45-degree field of view. Image size 2184x1690. Fundus photo — 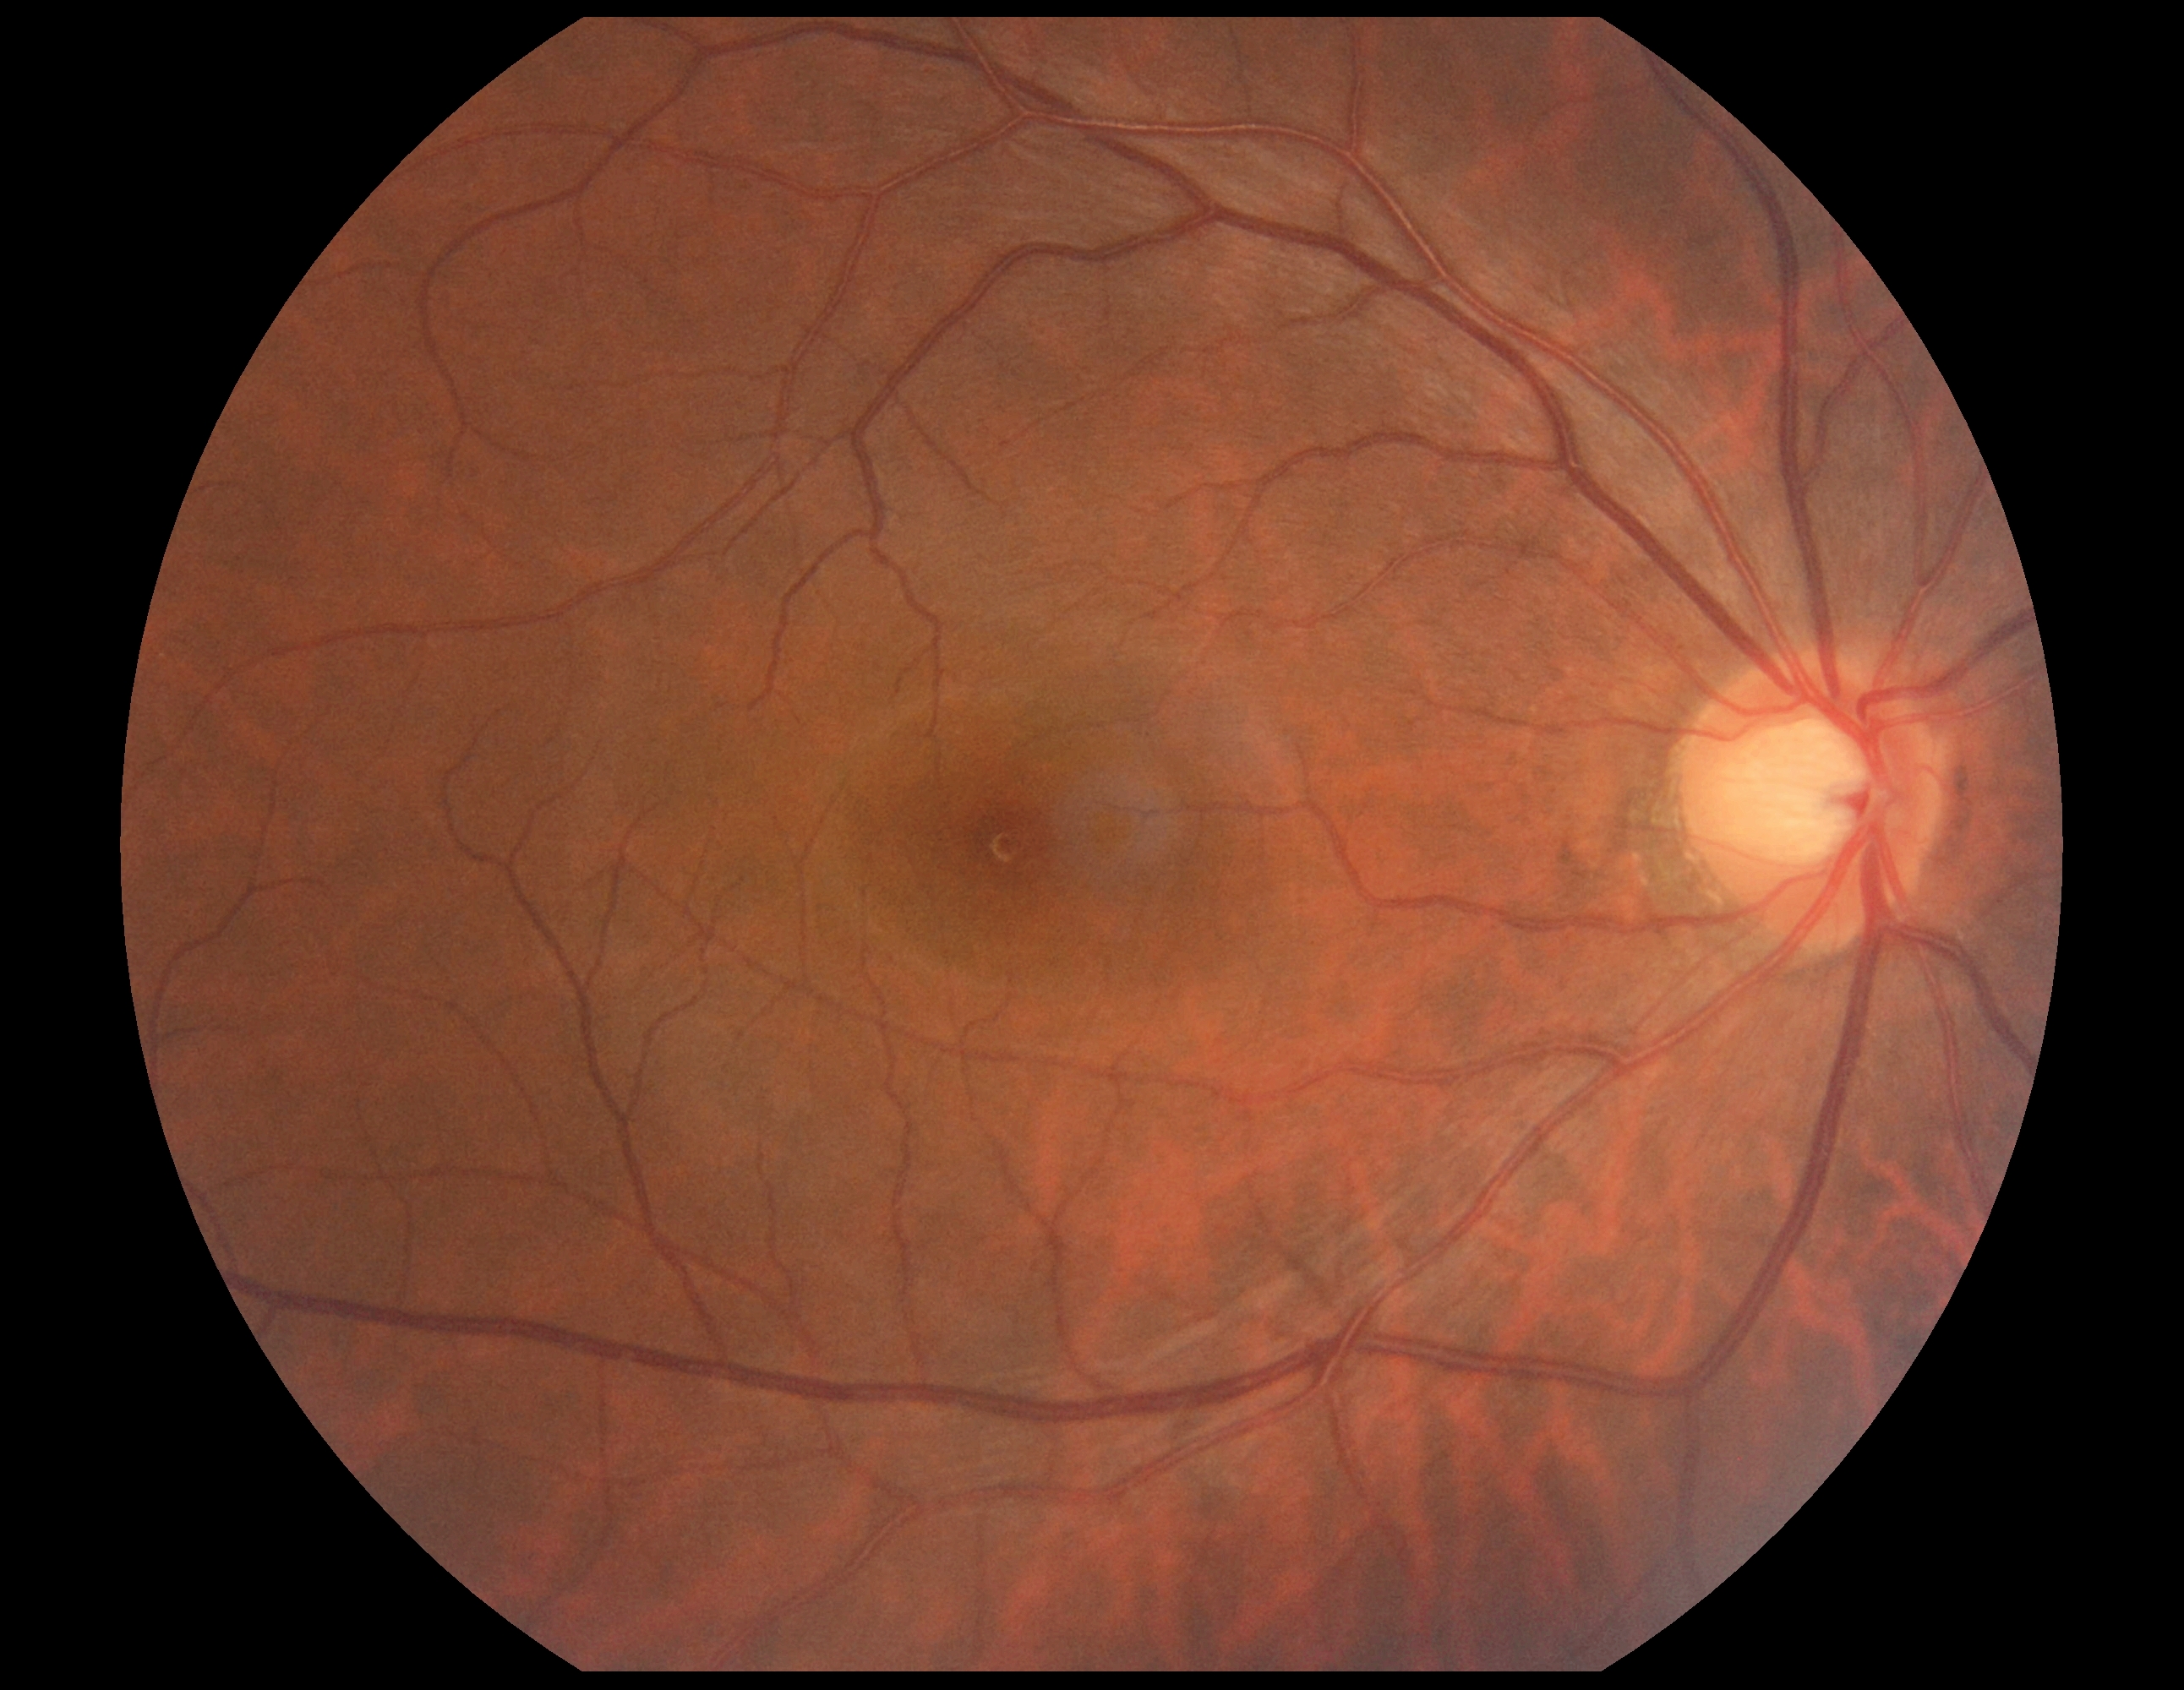 DR grade: 0 (no apparent retinopathy).